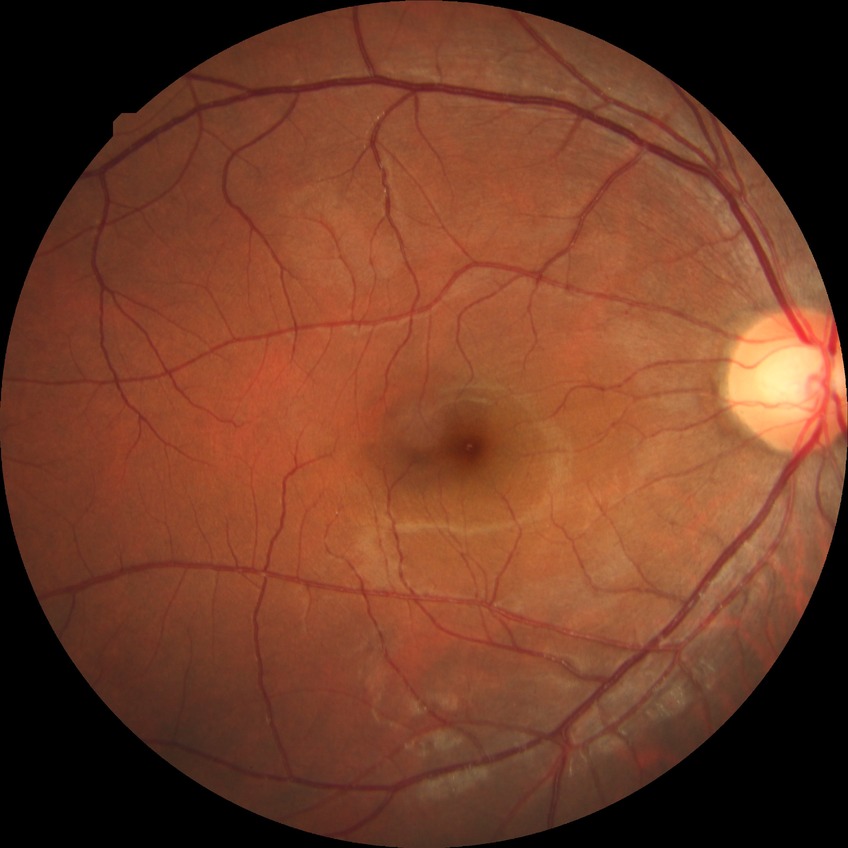

diabetic retinopathy (DR)@no diabetic retinopathy (NDR).